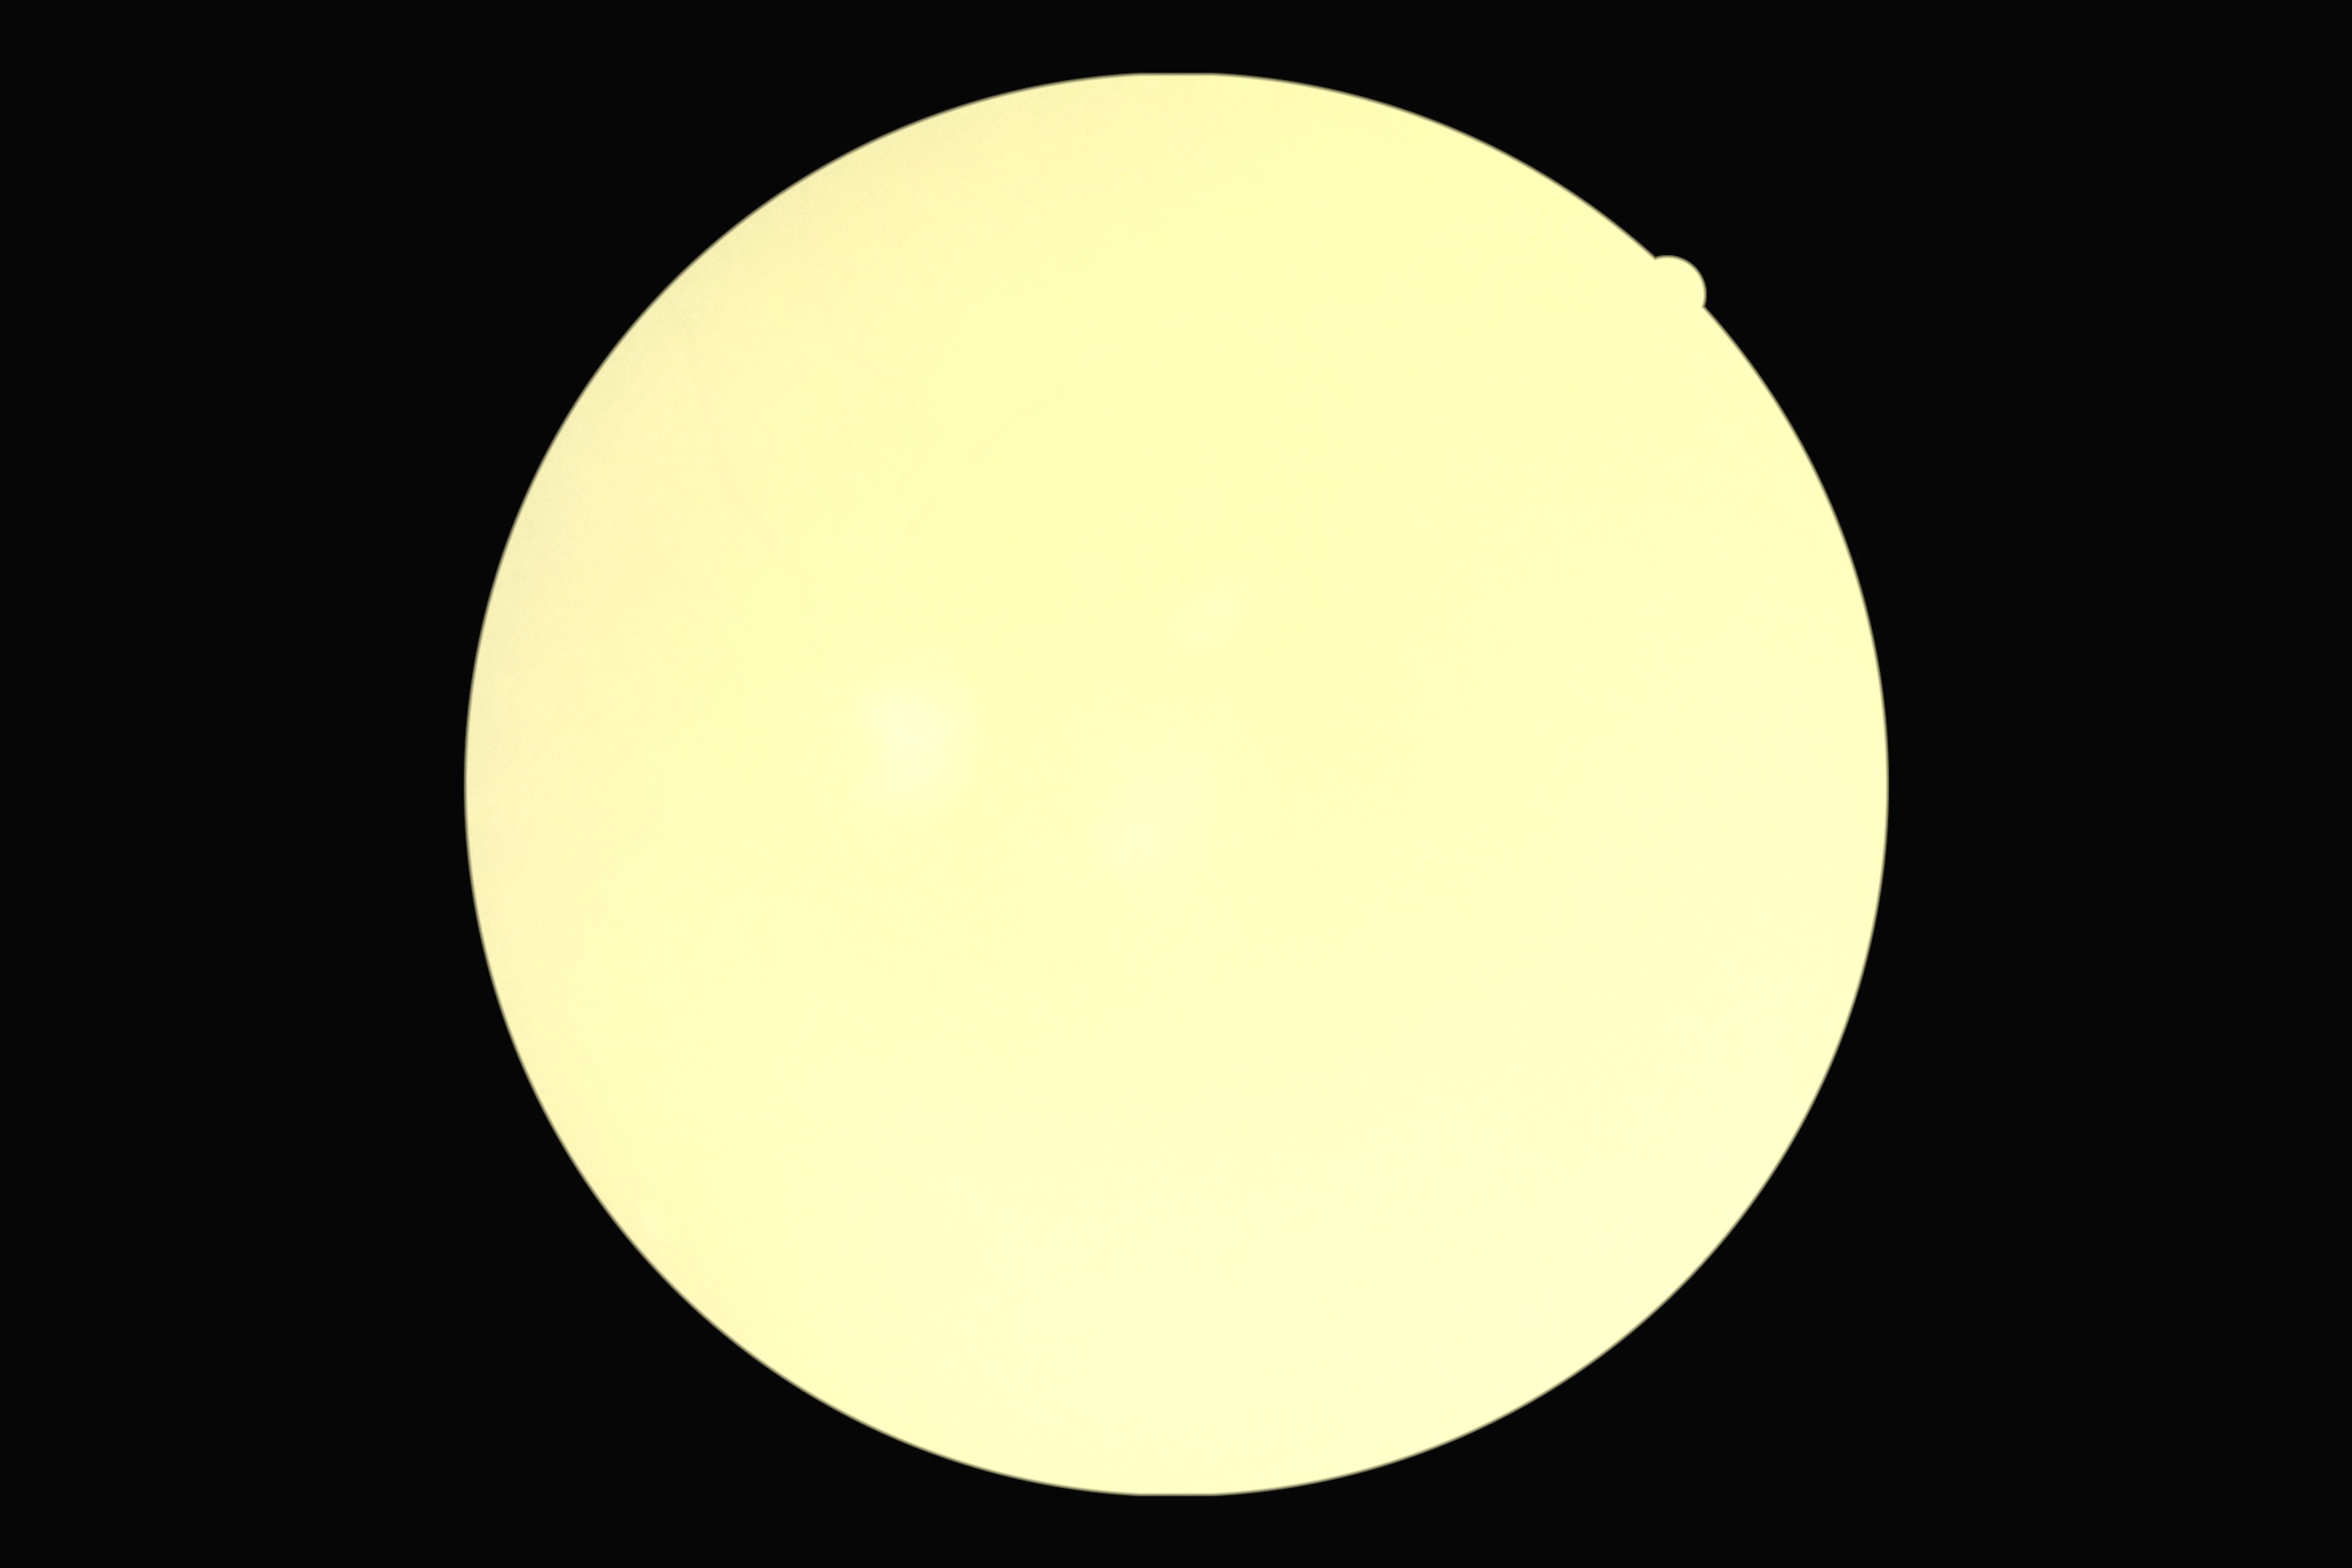
{"dr_grade": "ungradable due to poor image quality", "quality": "too poor for DR grading"}